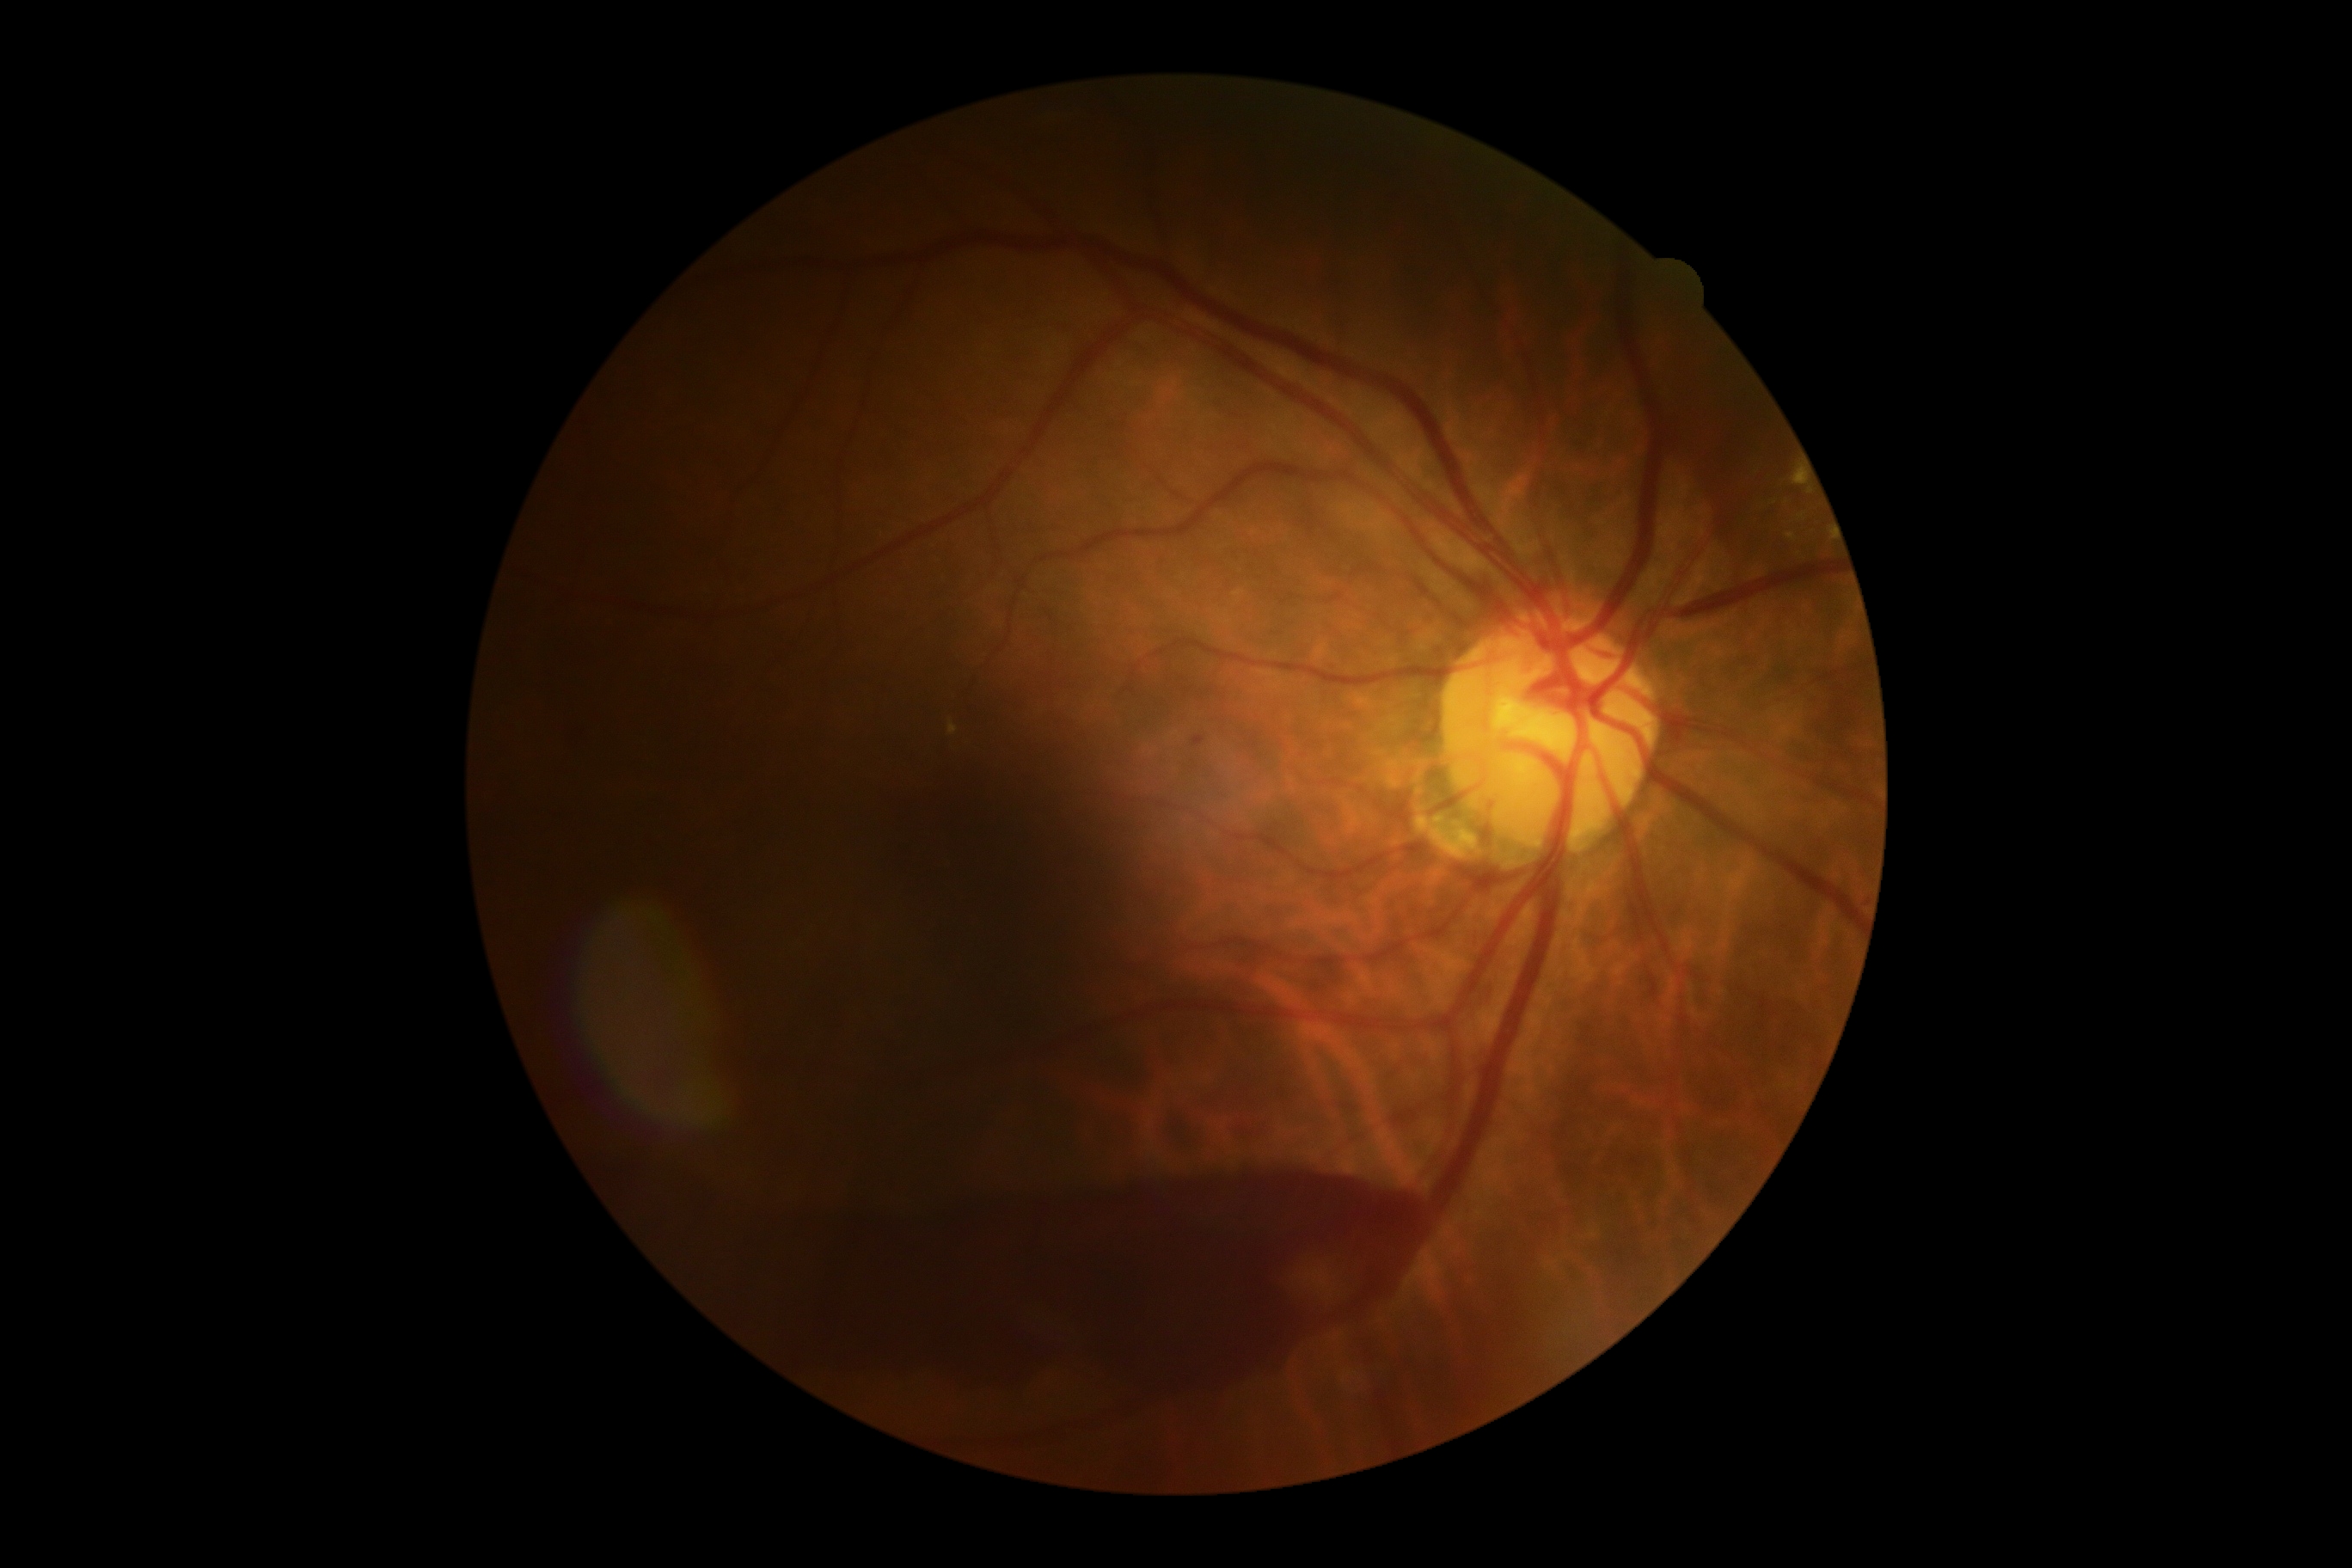

DR stage: 4/4.